NIDEK AFC-230 fundus camera. Nonmydriatic fundus photograph. 848x848. Posterior pole photograph. 45° field of view — 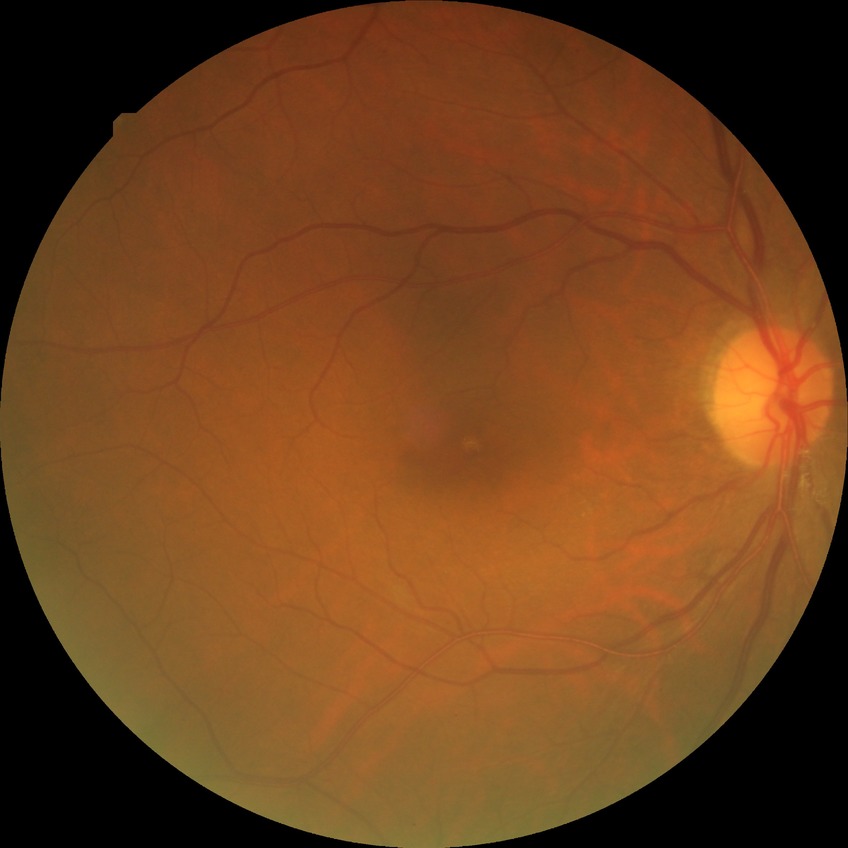 Diabetic retinopathy stage: simple diabetic retinopathy.